Diabetic retinopathy graded by the modified Davis classification · 45° field of view: 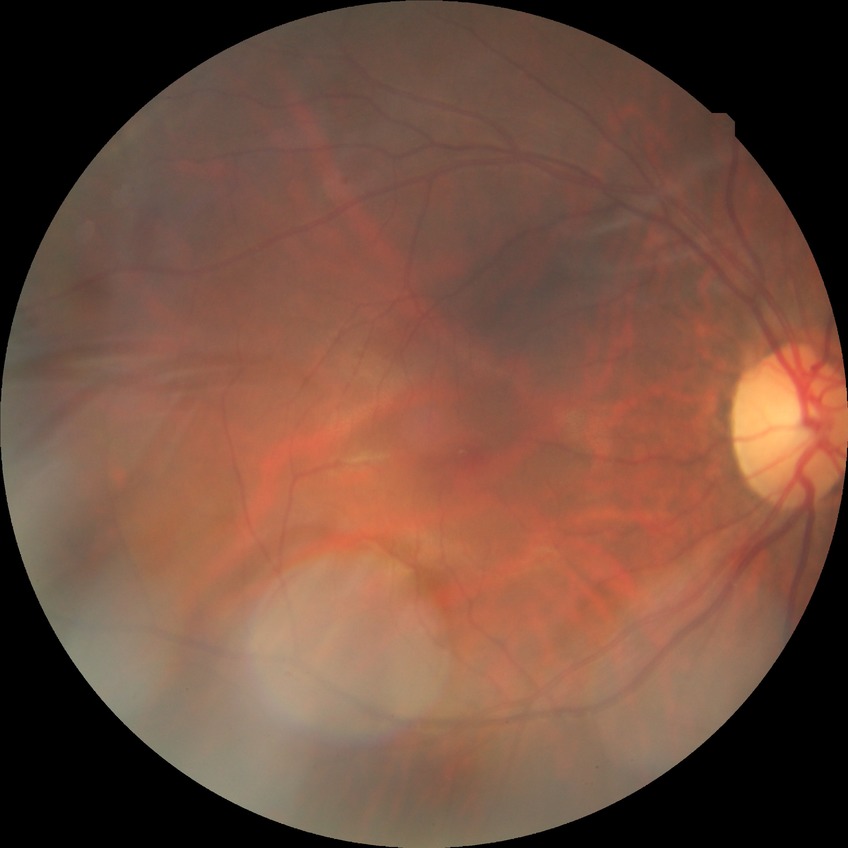 {
  "dr_impression": "no apparent DR",
  "davis_grade": "NDR"
}